Wide-field fundus photograph of an infant. Acquired on the Clarity RetCam 3. 640x480px.
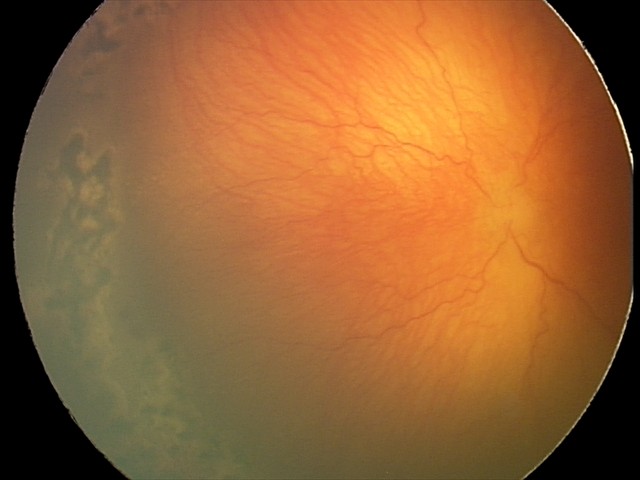
Q: What is the screening diagnosis?
A: A-ROP (aggressive ROP)
Q: Plus disease status?
A: plus disease — abnormal dilation and tortuosity of the posterior pole retinal vessels